2352x1568px · retinal fundus photograph
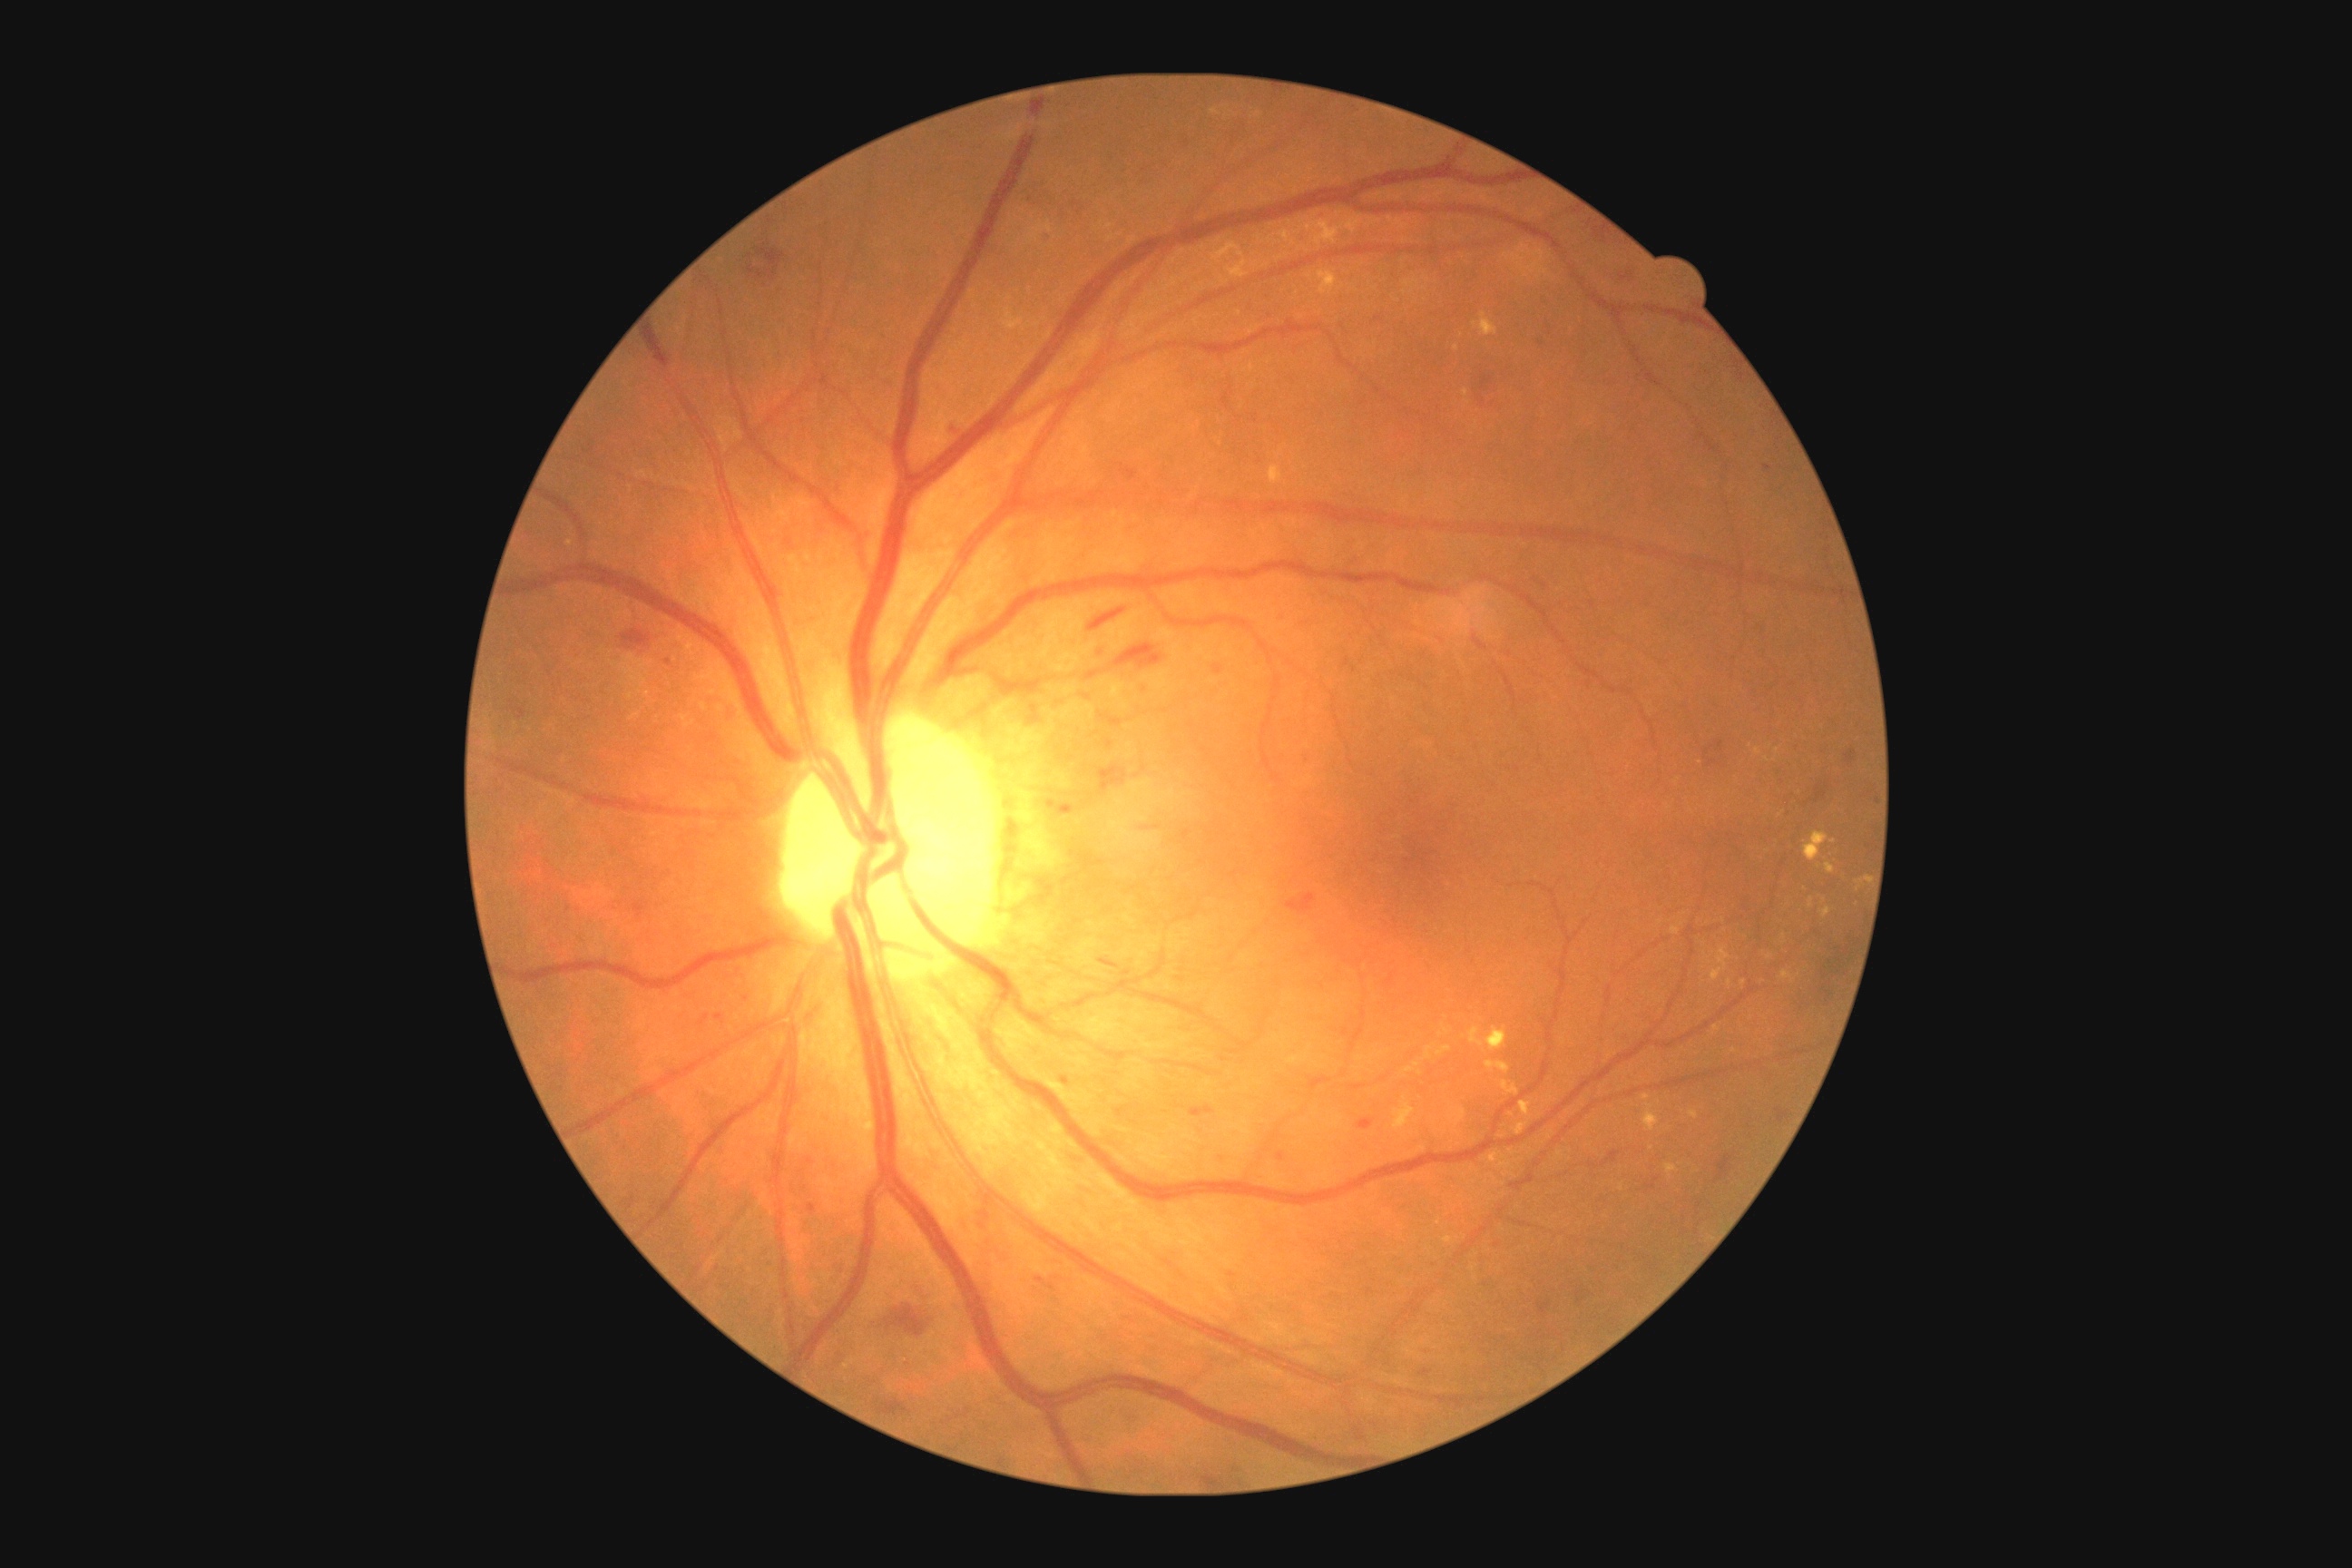 Diabetic retinopathy (DR) is grade 2 (moderate NPDR)
A subset of detected lesions:
microaneurysms (MAs): none identified
hard exudates (EXs) (continued): [x1=1485, y1=1061, x2=1511, y2=1073], [x1=1489, y1=1153, x2=1500, y2=1162], [x1=1805, y1=832, x2=1828, y2=861], [x1=1455, y1=1108, x2=1465, y2=1128], [x1=1642, y1=1093, x2=1651, y2=1101], [x1=1821, y1=908, x2=1832, y2=919], [x1=1306, y1=217, x2=1364, y2=248], [x1=1318, y1=271, x2=1338, y2=295], [x1=1442, y1=1026, x2=1449, y2=1034], [x1=1520, y1=1101, x2=1531, y2=1117]
Additional small EXs near (1729, 983), (1777, 751), (1785, 935), (1417, 1065), (1743, 983), (1758, 752)
soft exudates (SEs): none identified
hemorrhages (HEs) (continued): [x1=701, y1=1015, x2=709, y2=1024], [x1=1845, y1=750, x2=1856, y2=763], [x1=1106, y1=736, x2=1119, y2=756], [x1=1705, y1=747, x2=1714, y2=754], [x1=714, y1=1015, x2=723, y2=1021], [x1=1580, y1=217, x2=1614, y2=244], [x1=981, y1=1210, x2=990, y2=1220], [x1=1288, y1=894, x2=1317, y2=914], [x1=1538, y1=293, x2=1551, y2=308], [x1=1612, y1=268, x2=1638, y2=286], [x1=1469, y1=368, x2=1500, y2=409], [x1=1041, y1=231, x2=1054, y2=242], [x1=1099, y1=959, x2=1121, y2=968]
Additional small HEs near (1550, 334), (1580, 1295), (1370, 1291)